Color fundus image; 45° field of view; 848 x 848 pixels:
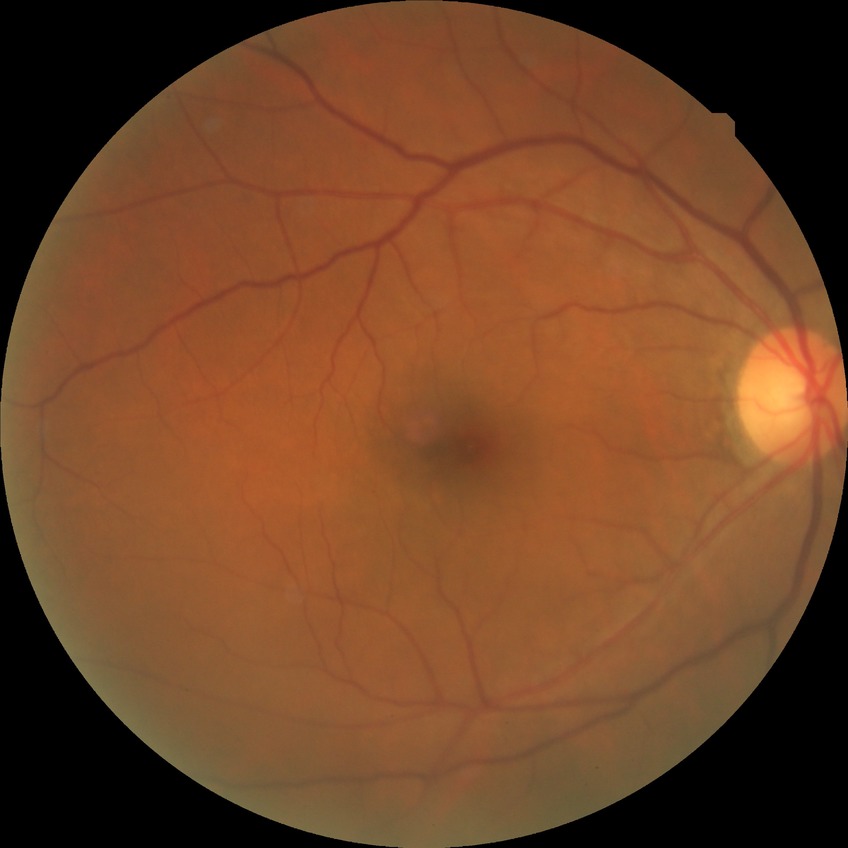

Diabetic retinopathy (DR) is NDR (no diabetic retinopathy).